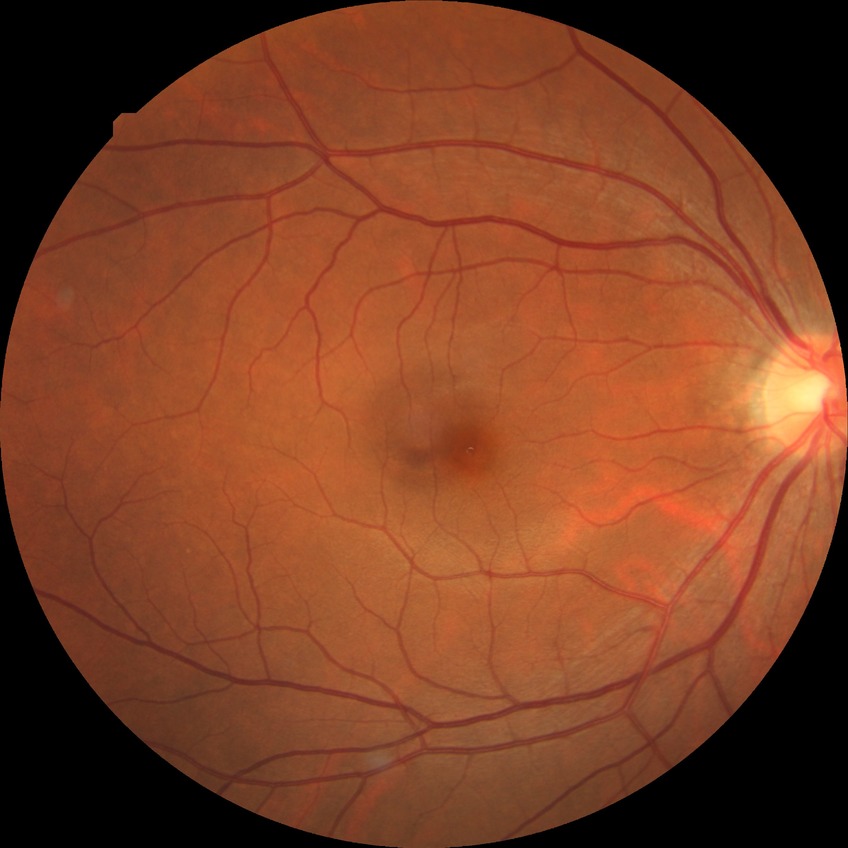

Retinopathy stage is simple diabetic retinopathy.